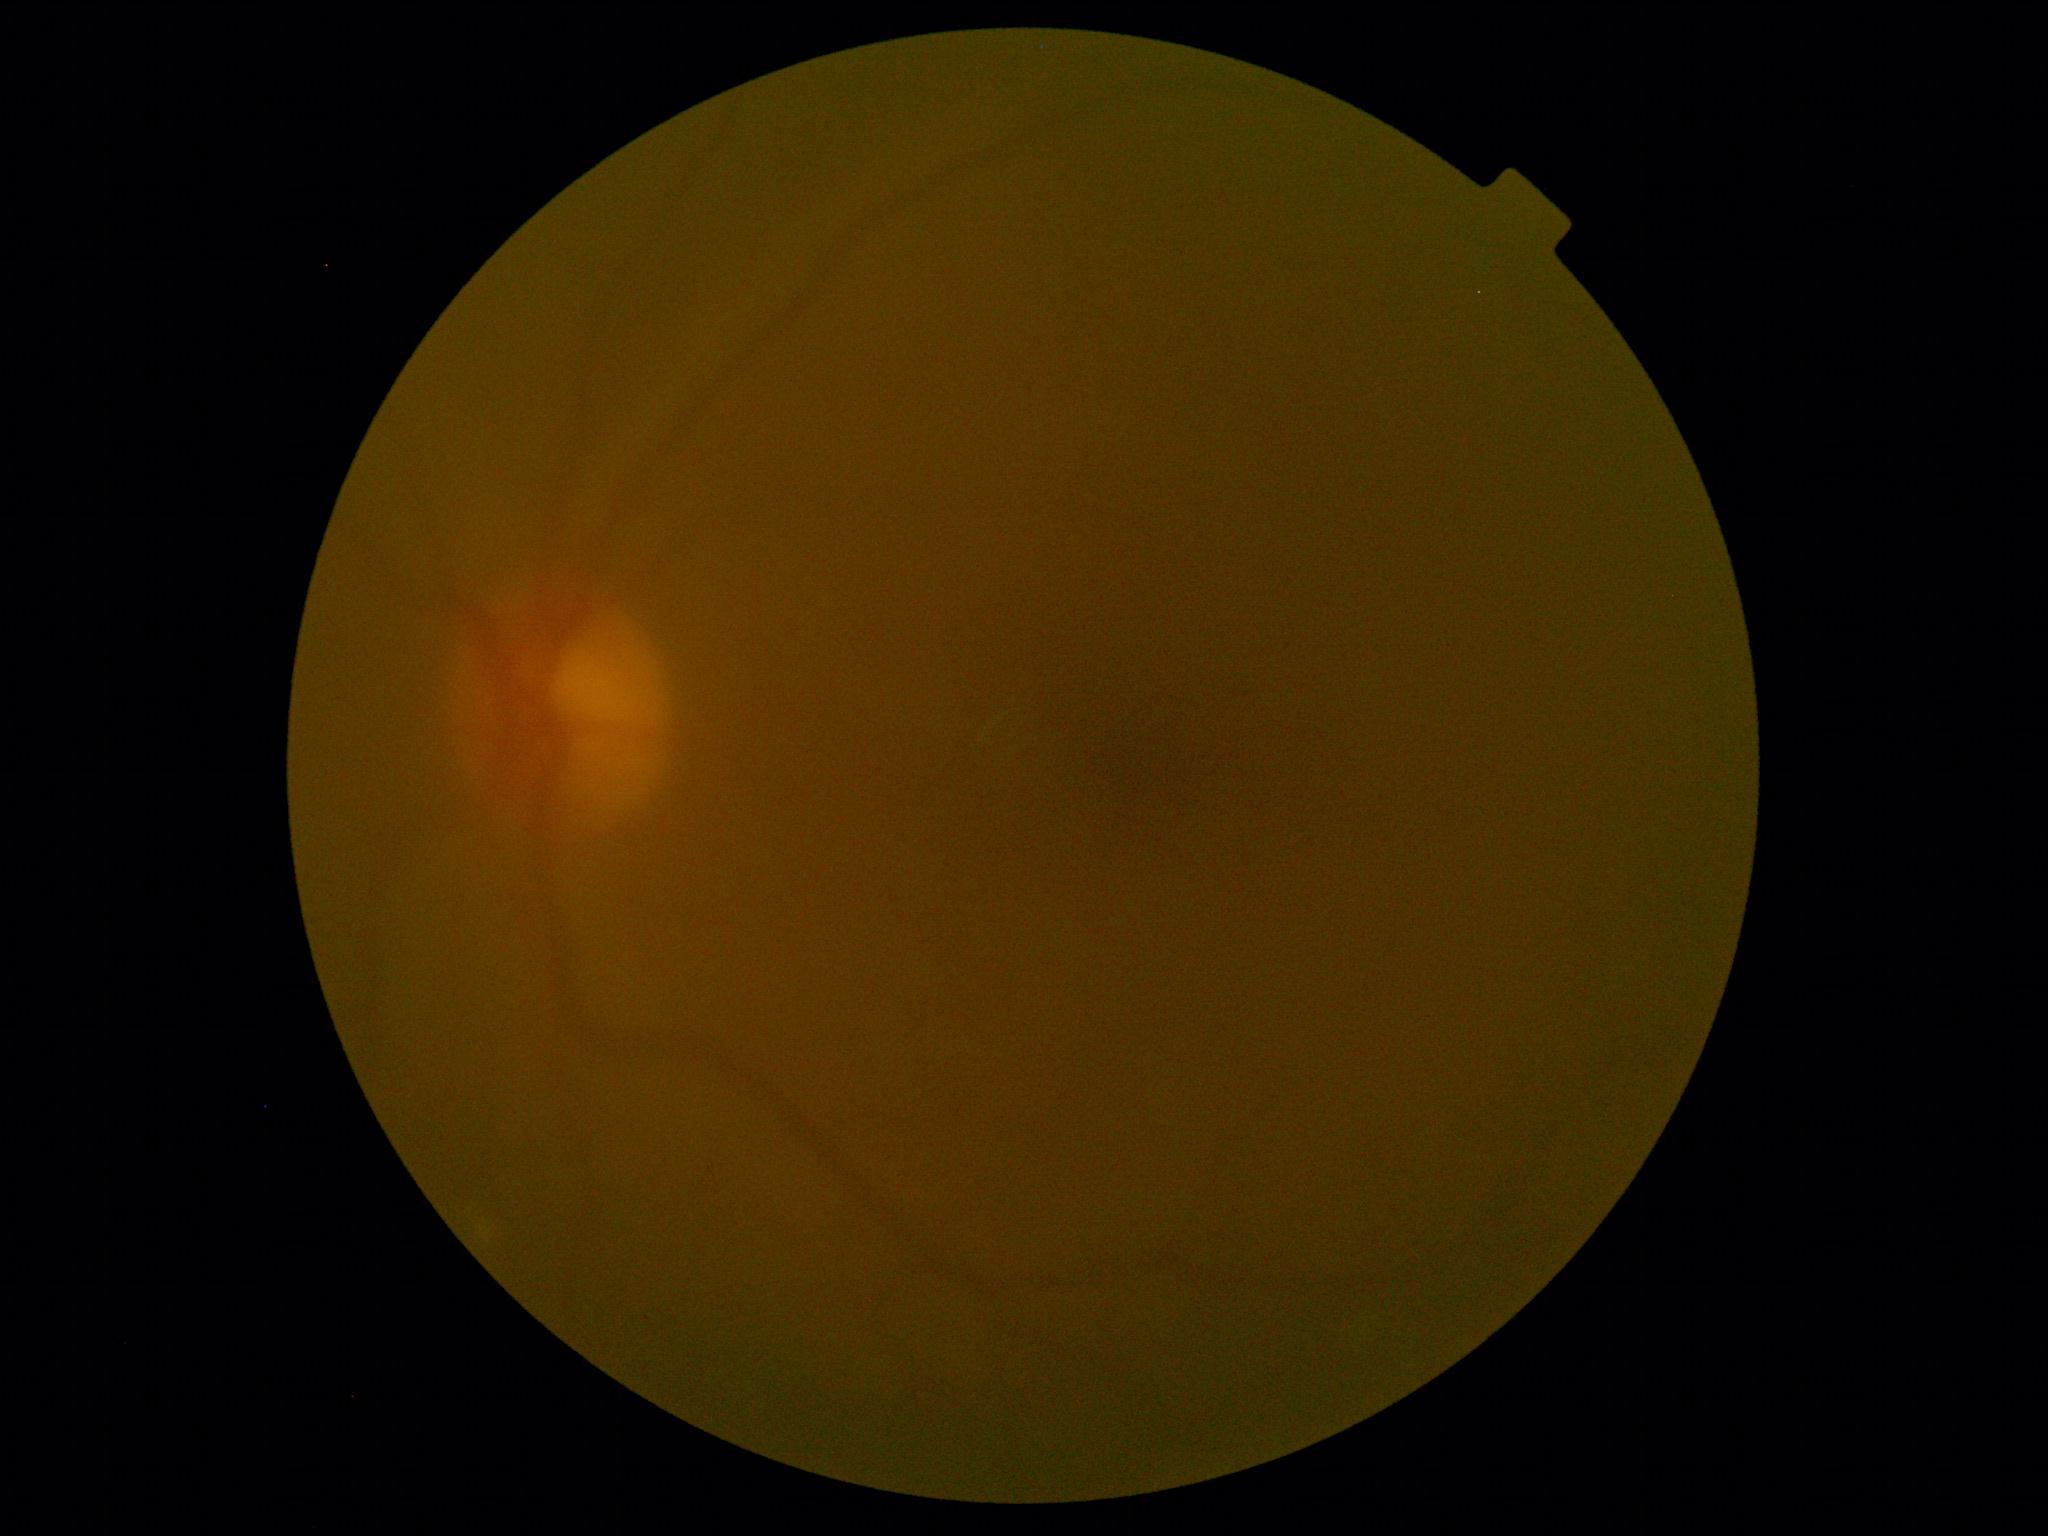 {
  "dr_grade": "ungradable"
}